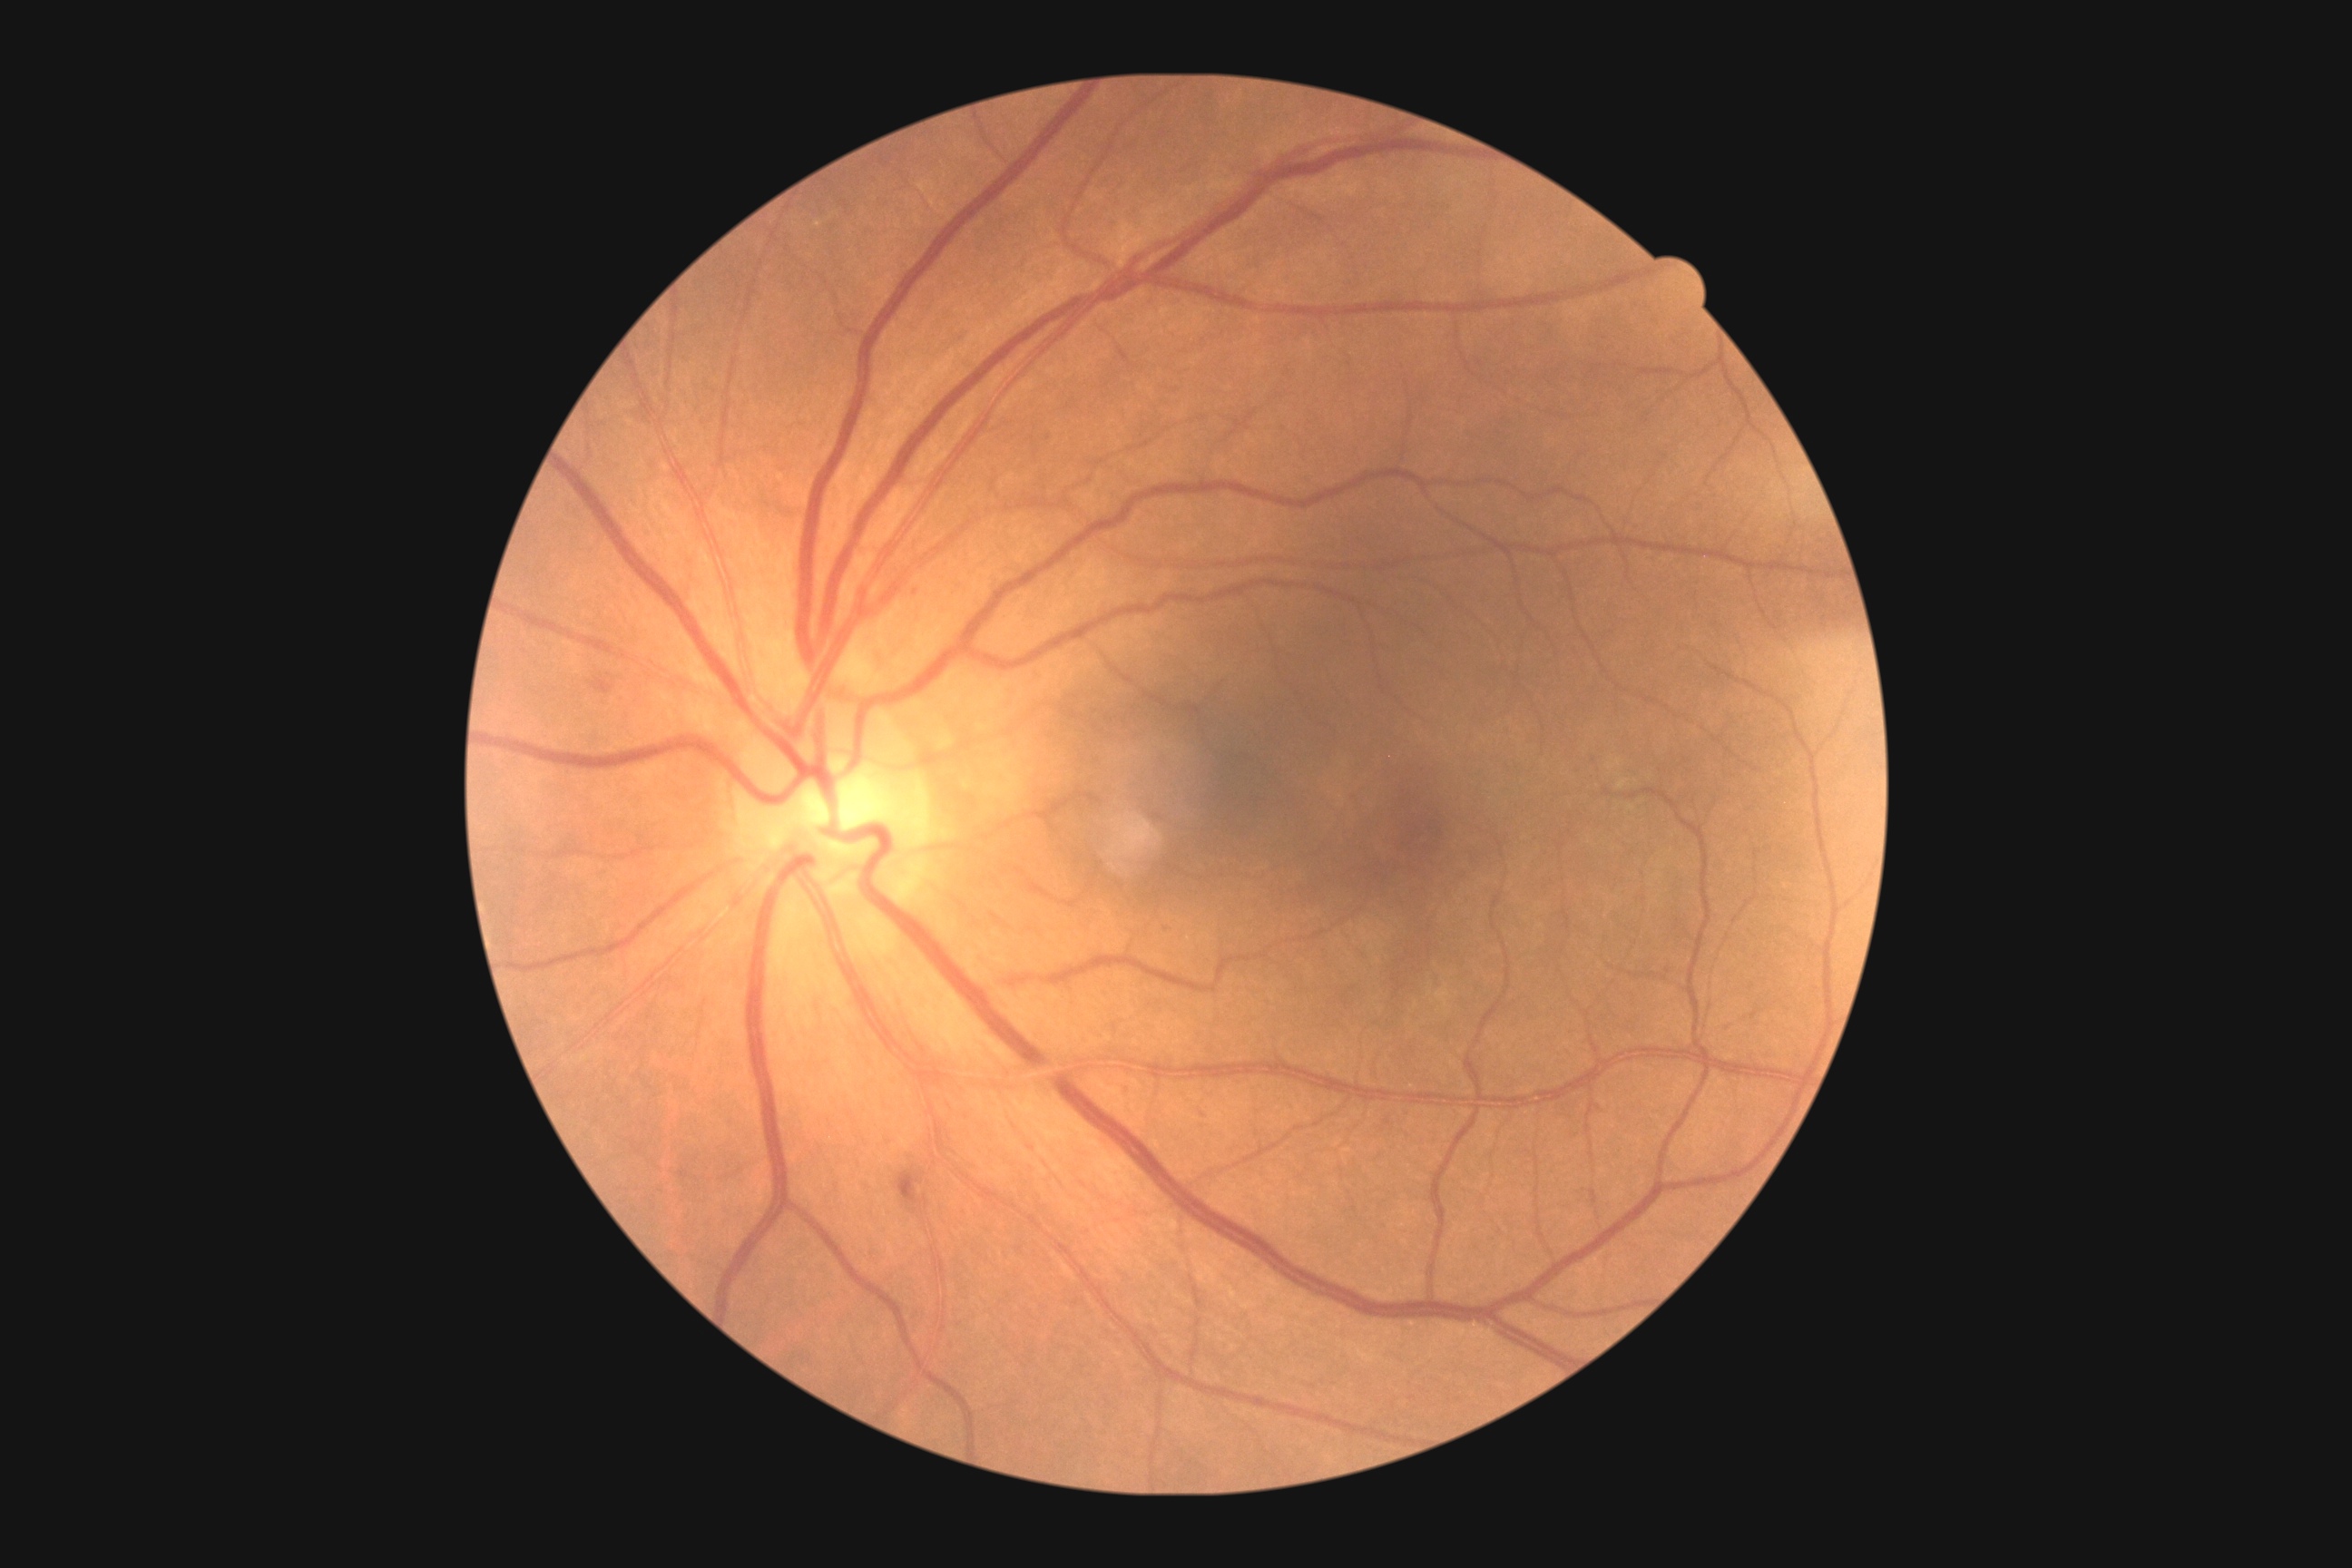 DR stage: 2.